848x848px. NIDEK AFC-230 fundus camera. Nonmydriatic:
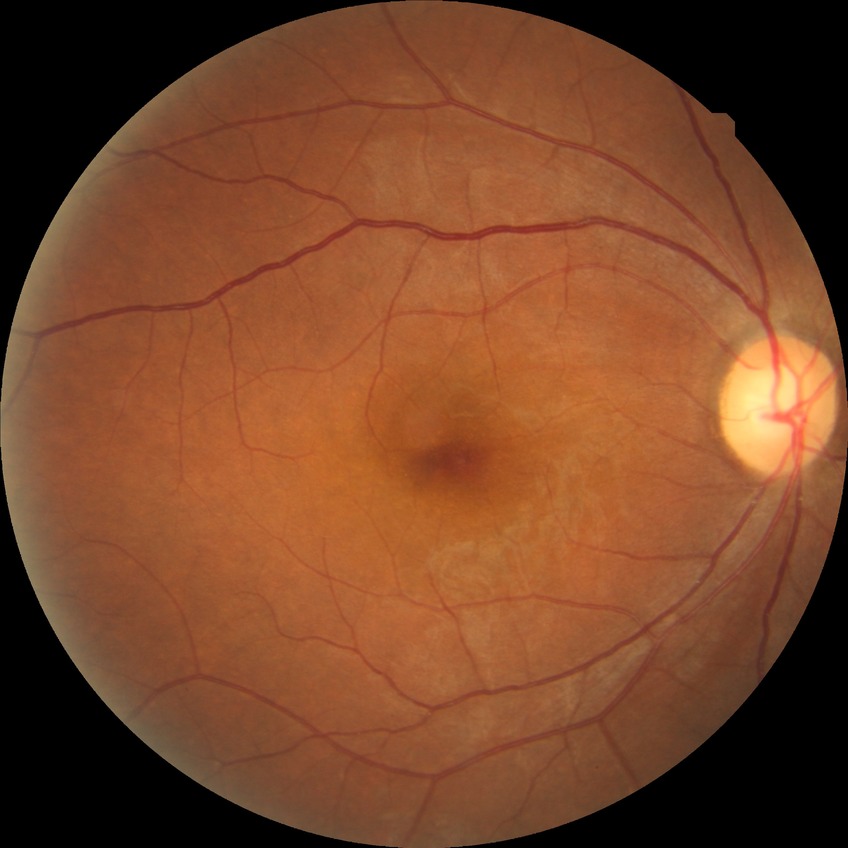 Diabetic retinopathy (DR): NDR (no diabetic retinopathy).